45° field of view — 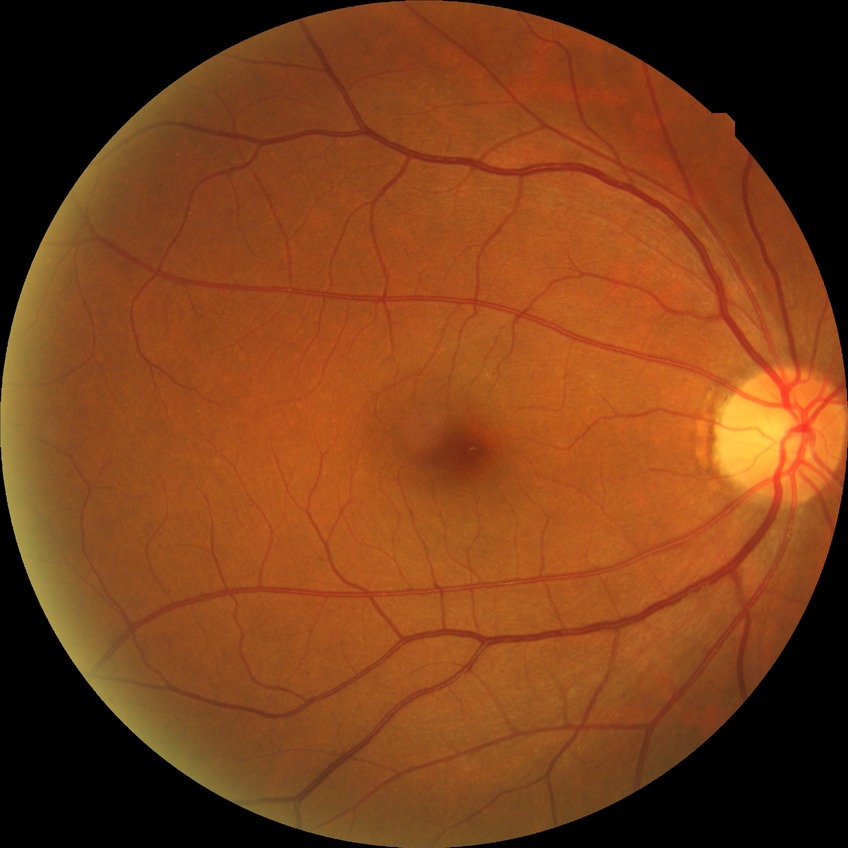
diabetic retinopathy severity=no diabetic retinopathy.